Wide-field fundus photograph from neonatal ROP screening · 640 x 480 pixels · camera: Clarity RetCam 3 (130° FOV)
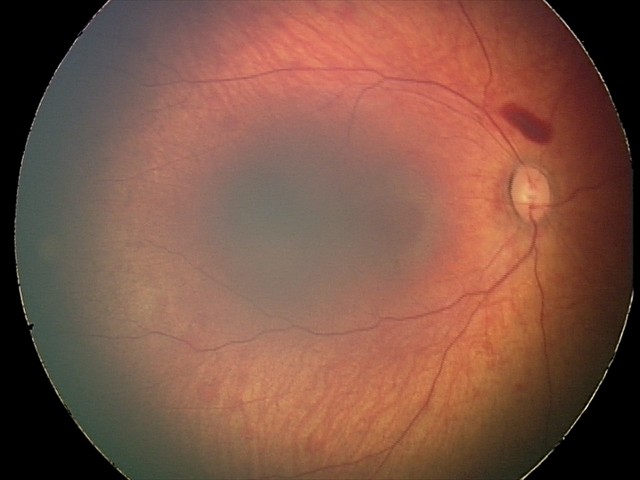 Impression: retinal hemorrhages.